2228 x 1652 pixels.
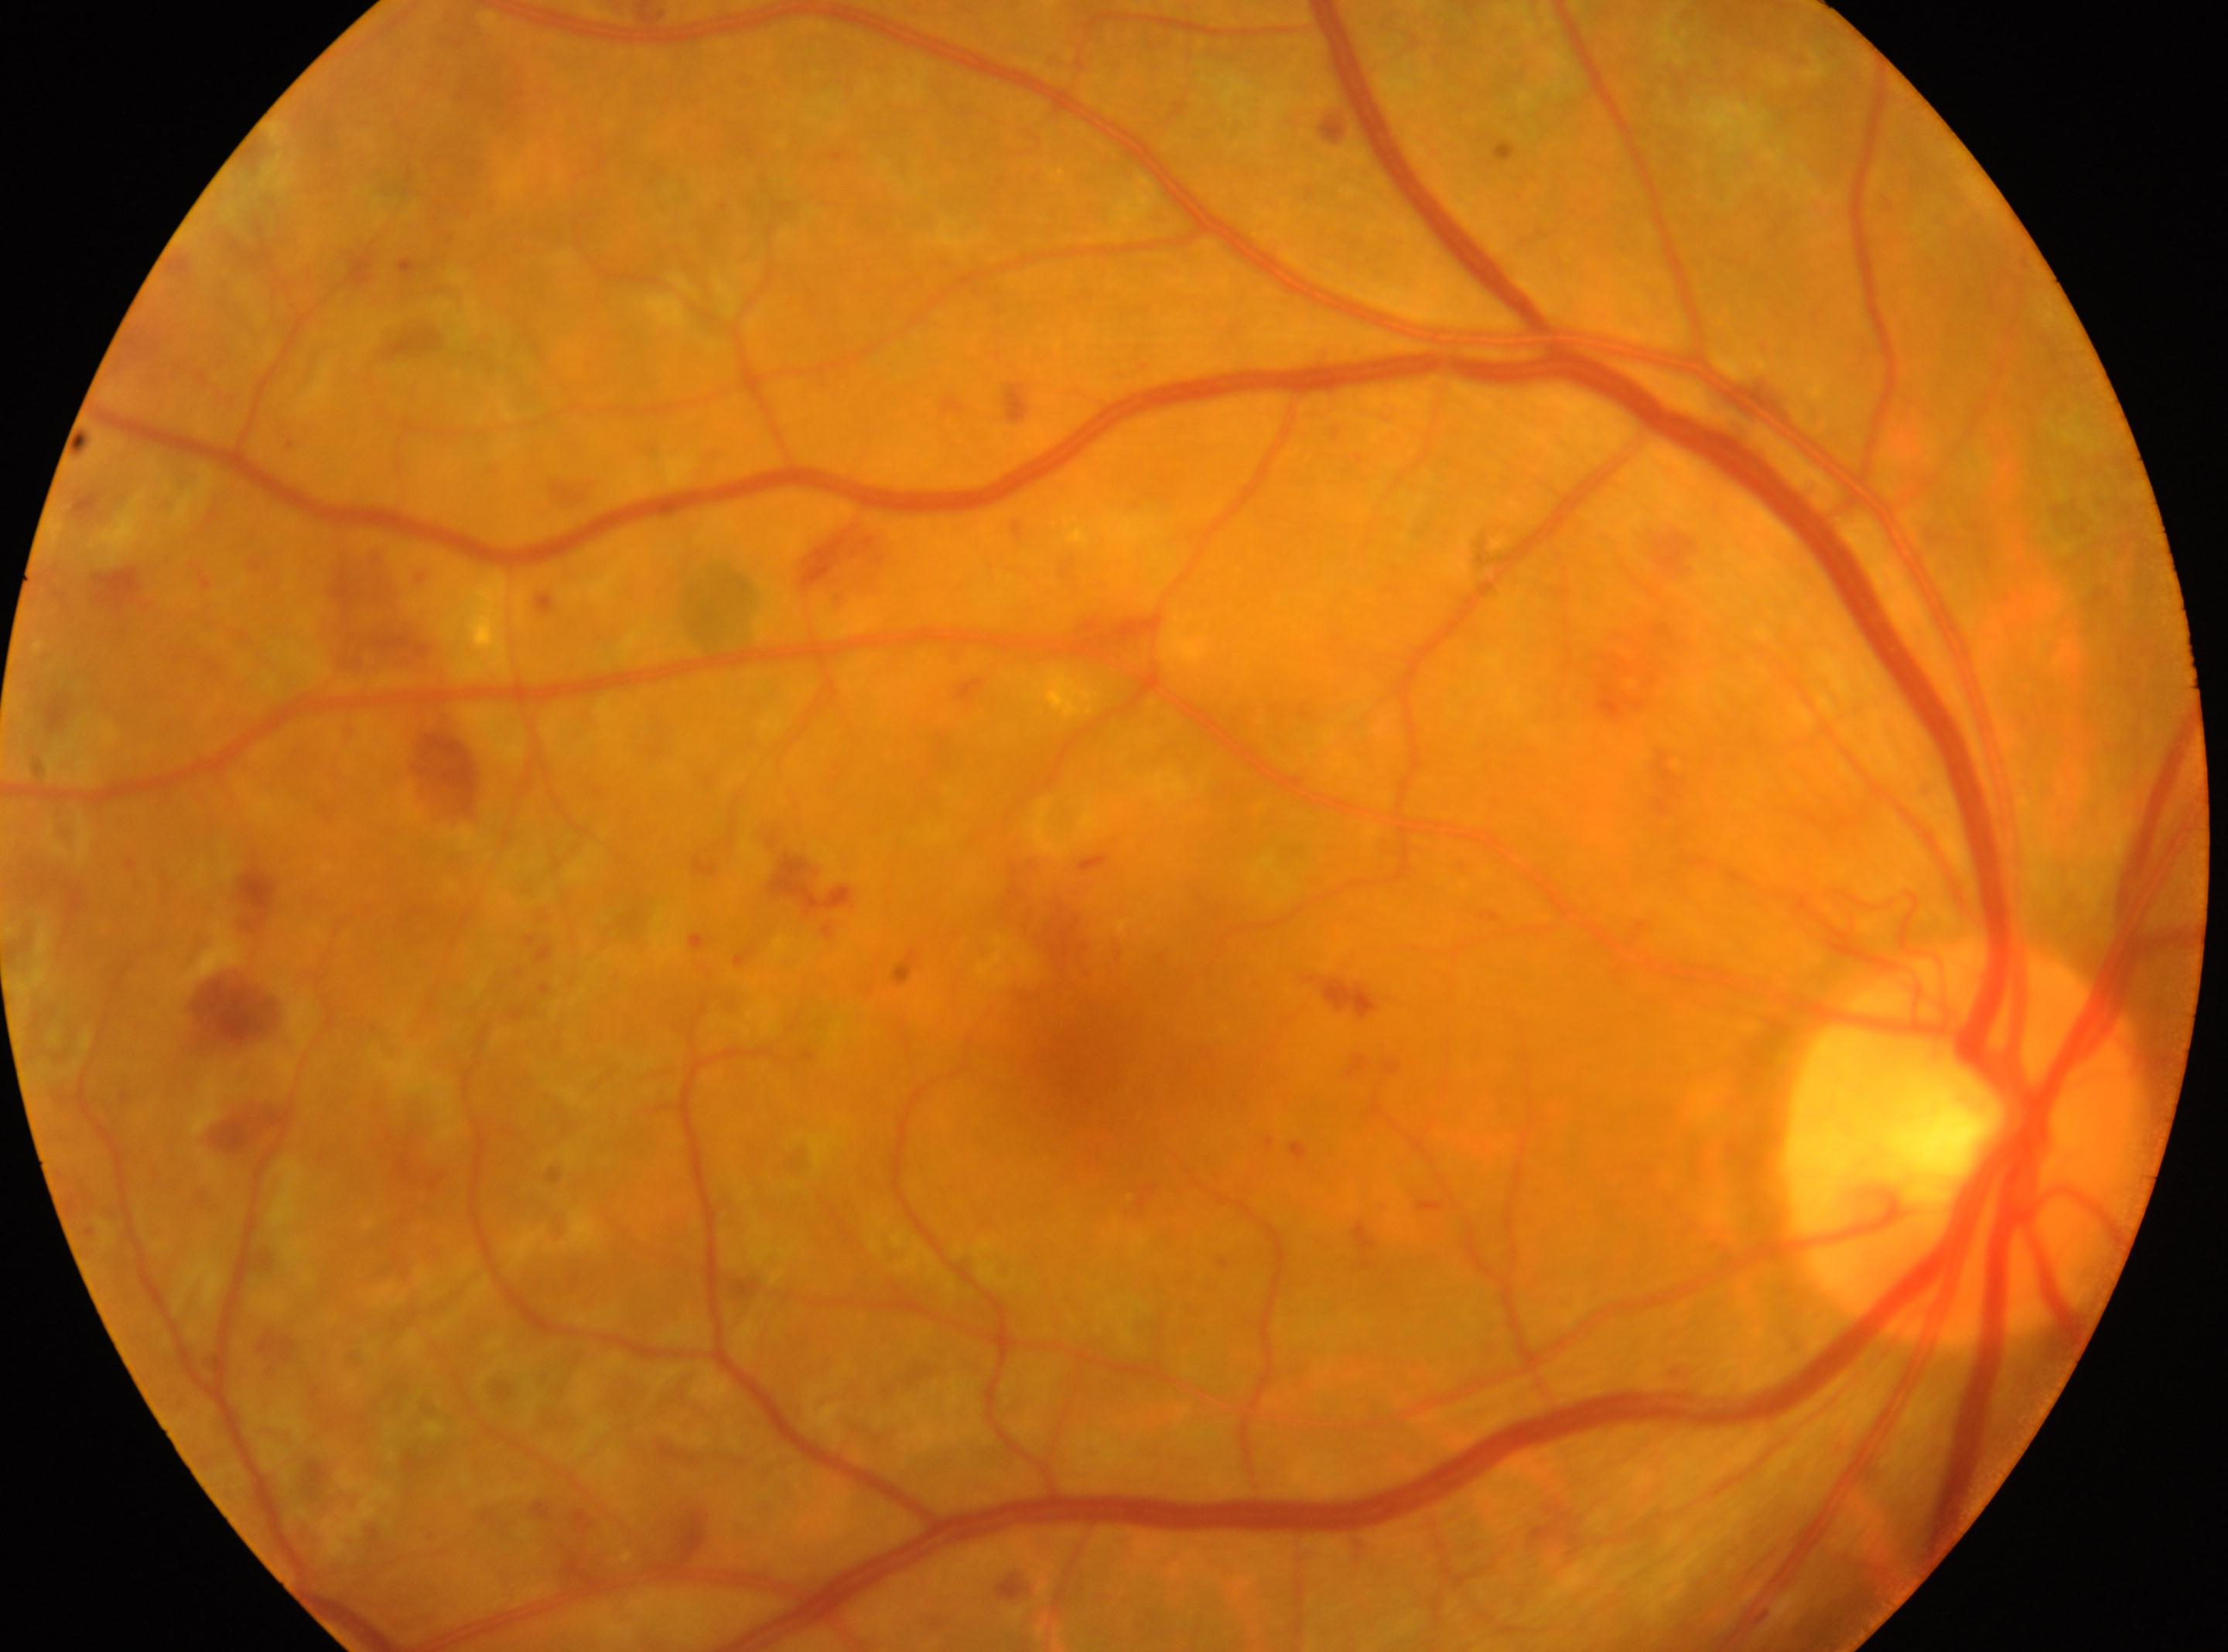

macular center: [1083, 1052]; disc center: [1963, 1142]; laterality: right eye; retinopathy: DR with laser photocoagulation scars, reclassified as severe non-proliferative diabetic retinopathy (grade 3).